FOV: 45 degrees
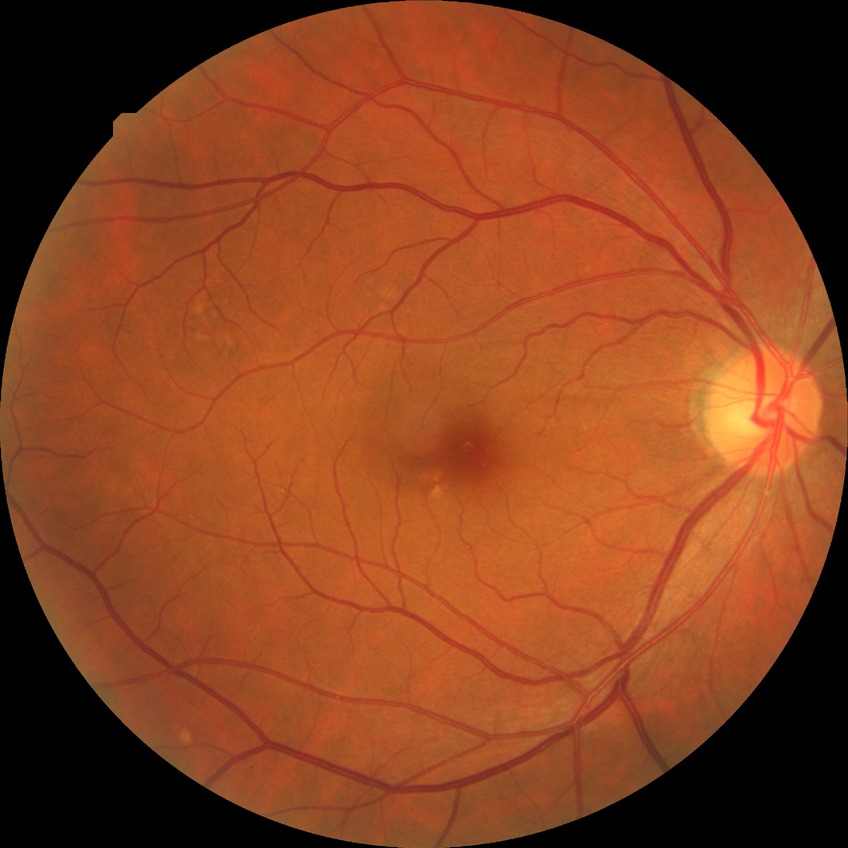
Modified Davis grading: no diabetic retinopathy.